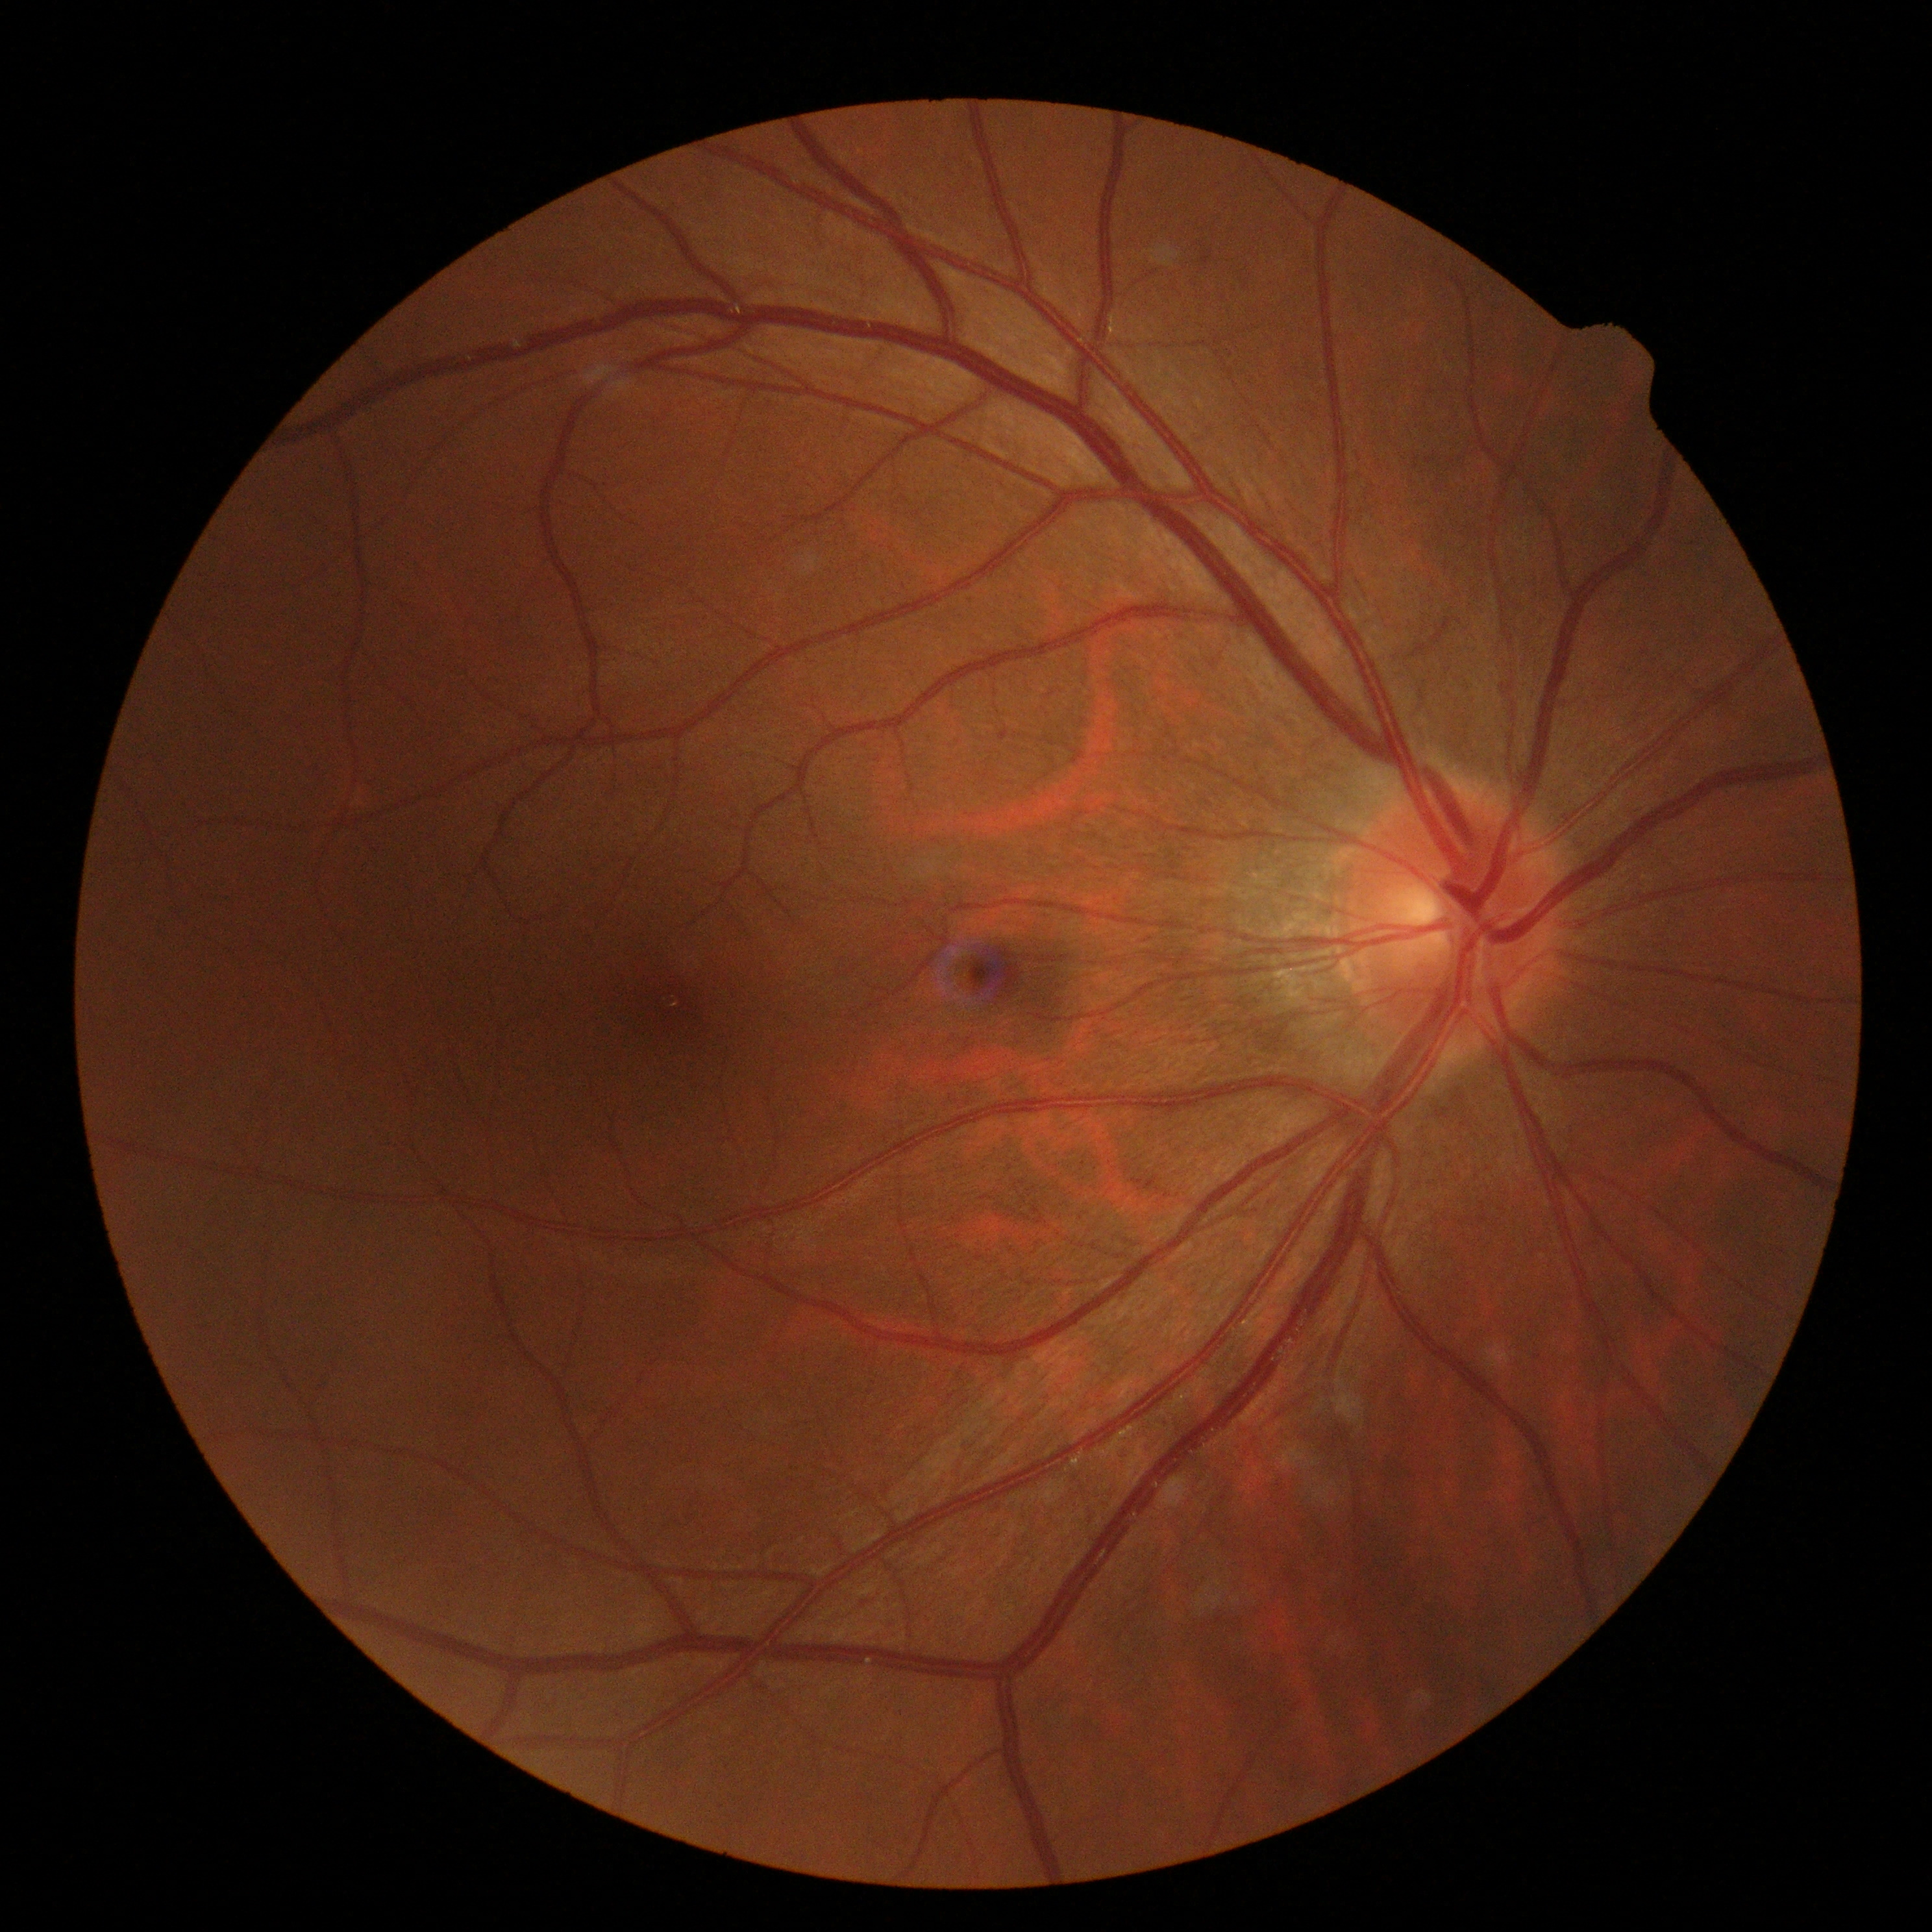
{
  "dr_grade": "grade 0 — no visible signs of diabetic retinopathy"
}